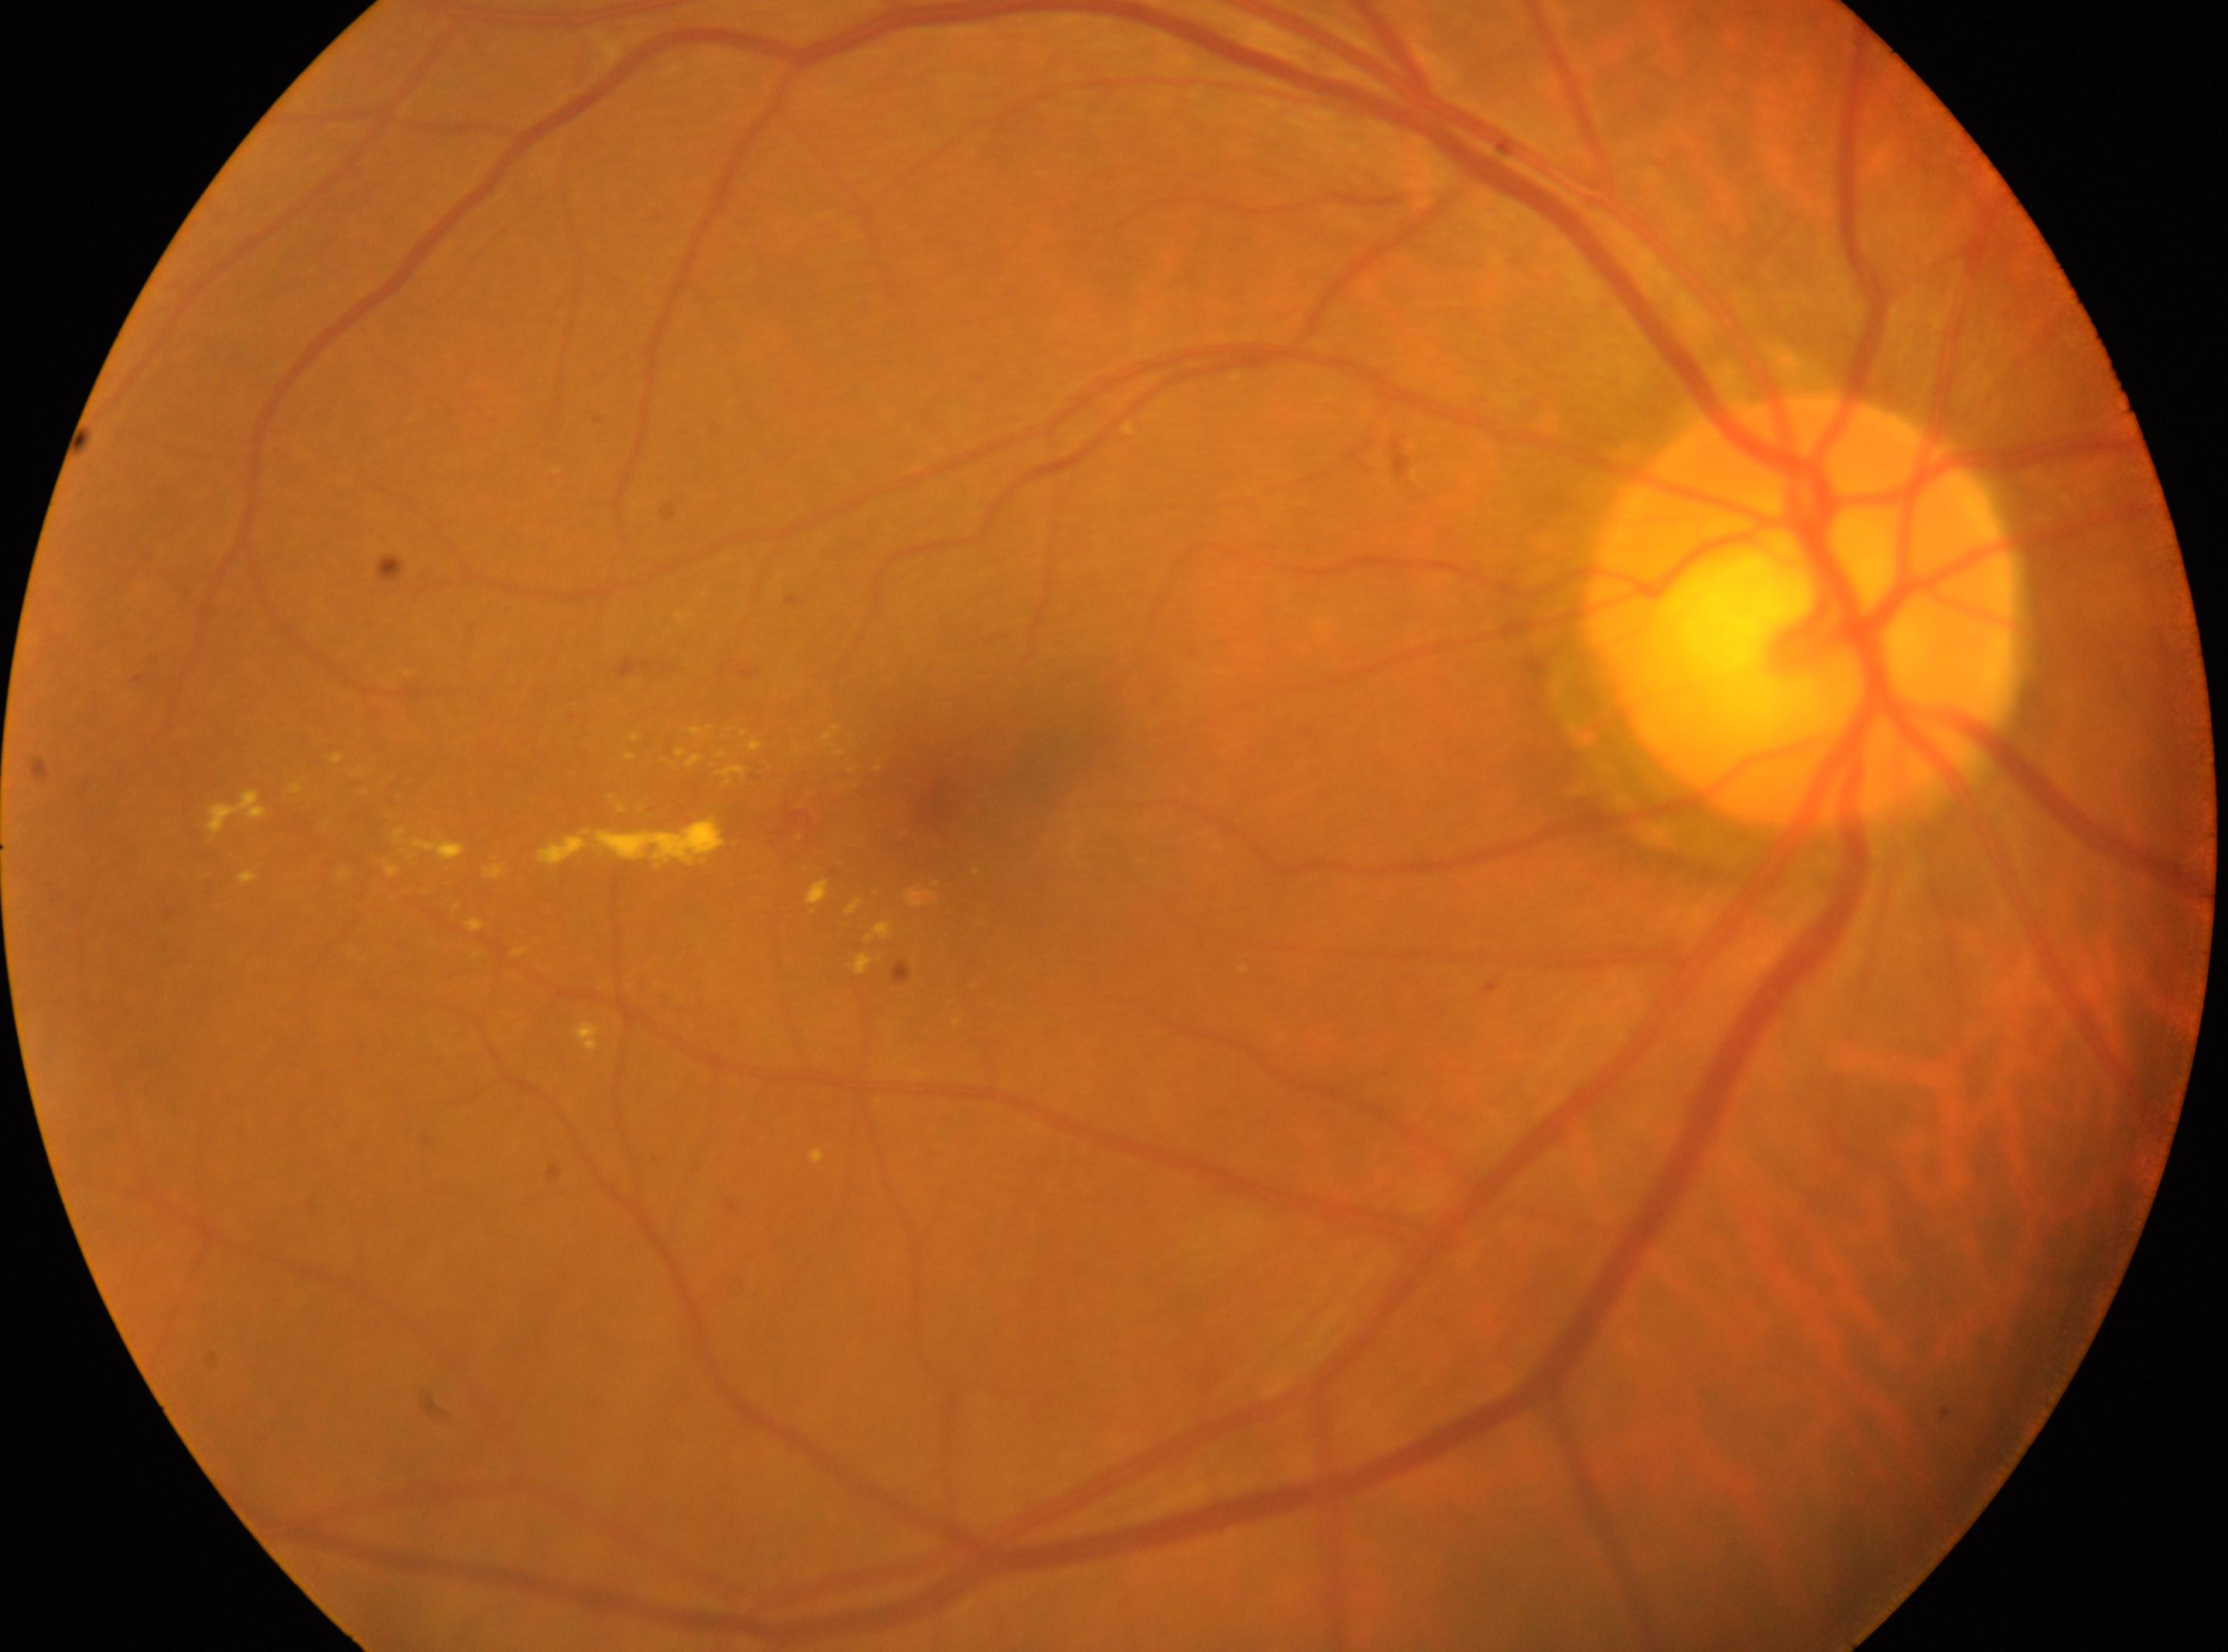

Optic disc center: 1804, 609.
Fovea centralis located at 948, 801.
Retinopathy is moderate non-proliferative diabetic retinopathy (grade 2).
Imaged eye: OD.